FOV: 45 degrees · CFP.
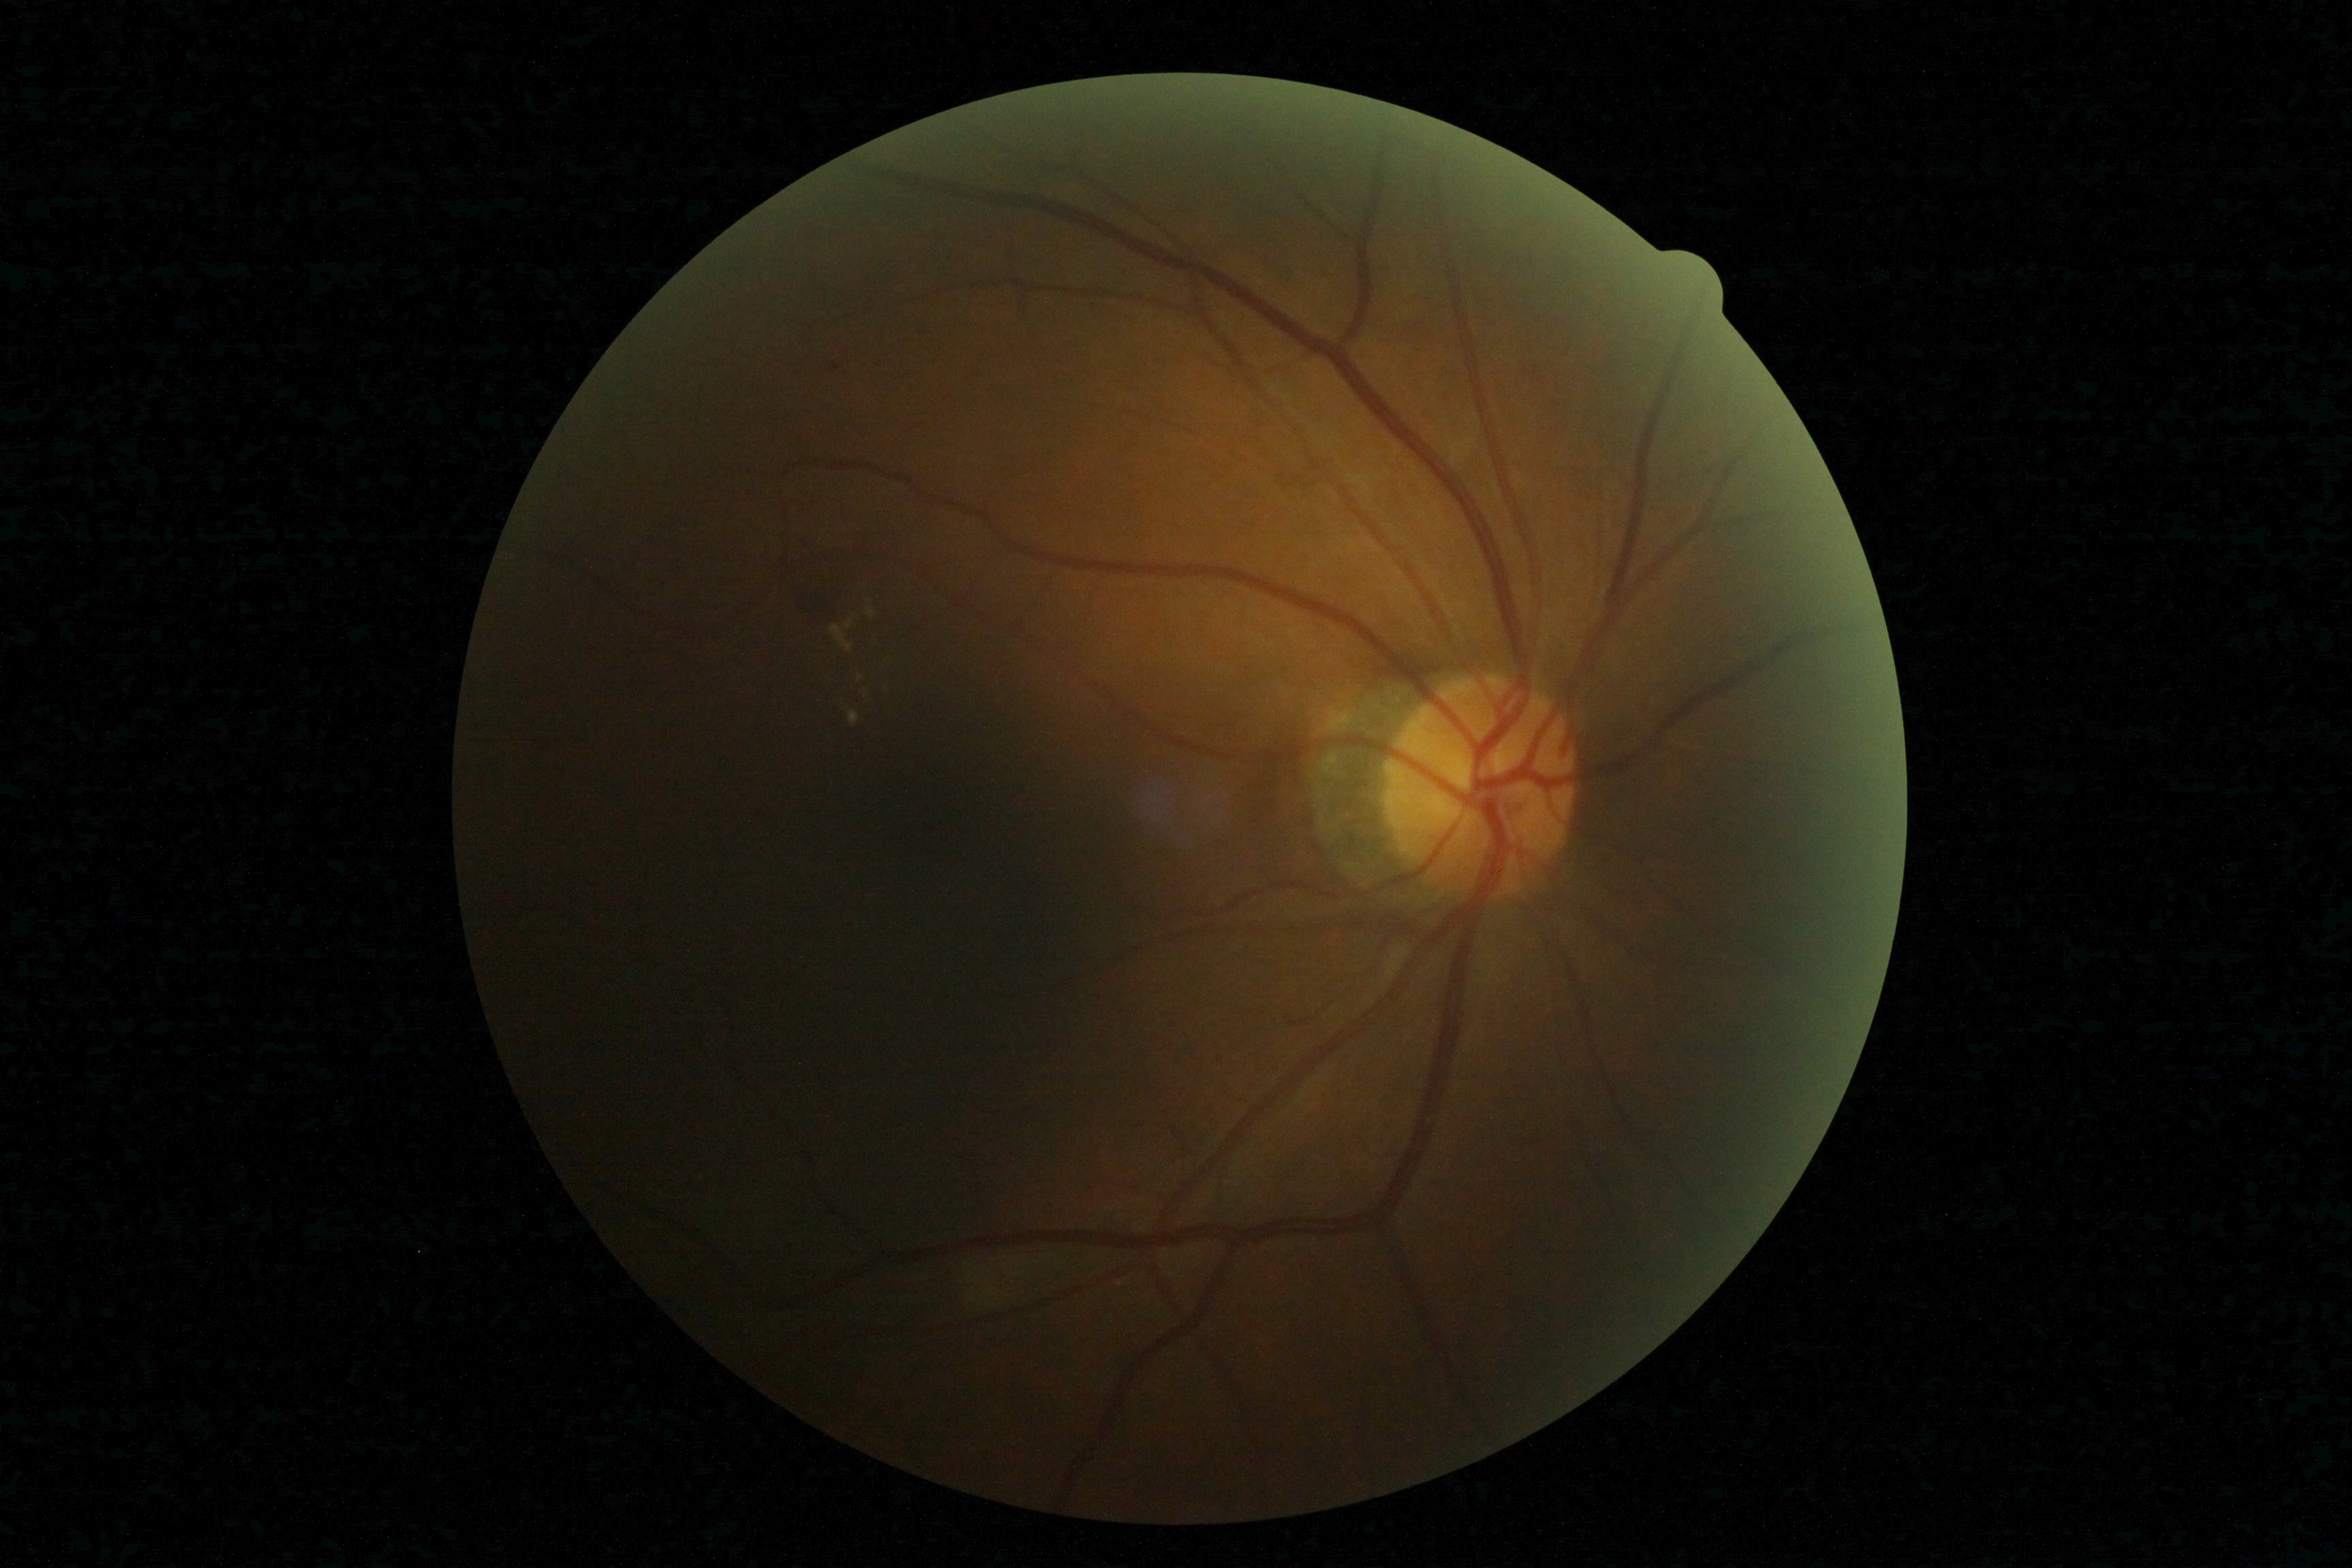

Diabetic retinopathy (DR): grade 2 (moderate NPDR).